Retinal fundus photograph. 1659 x 2212 pixels — 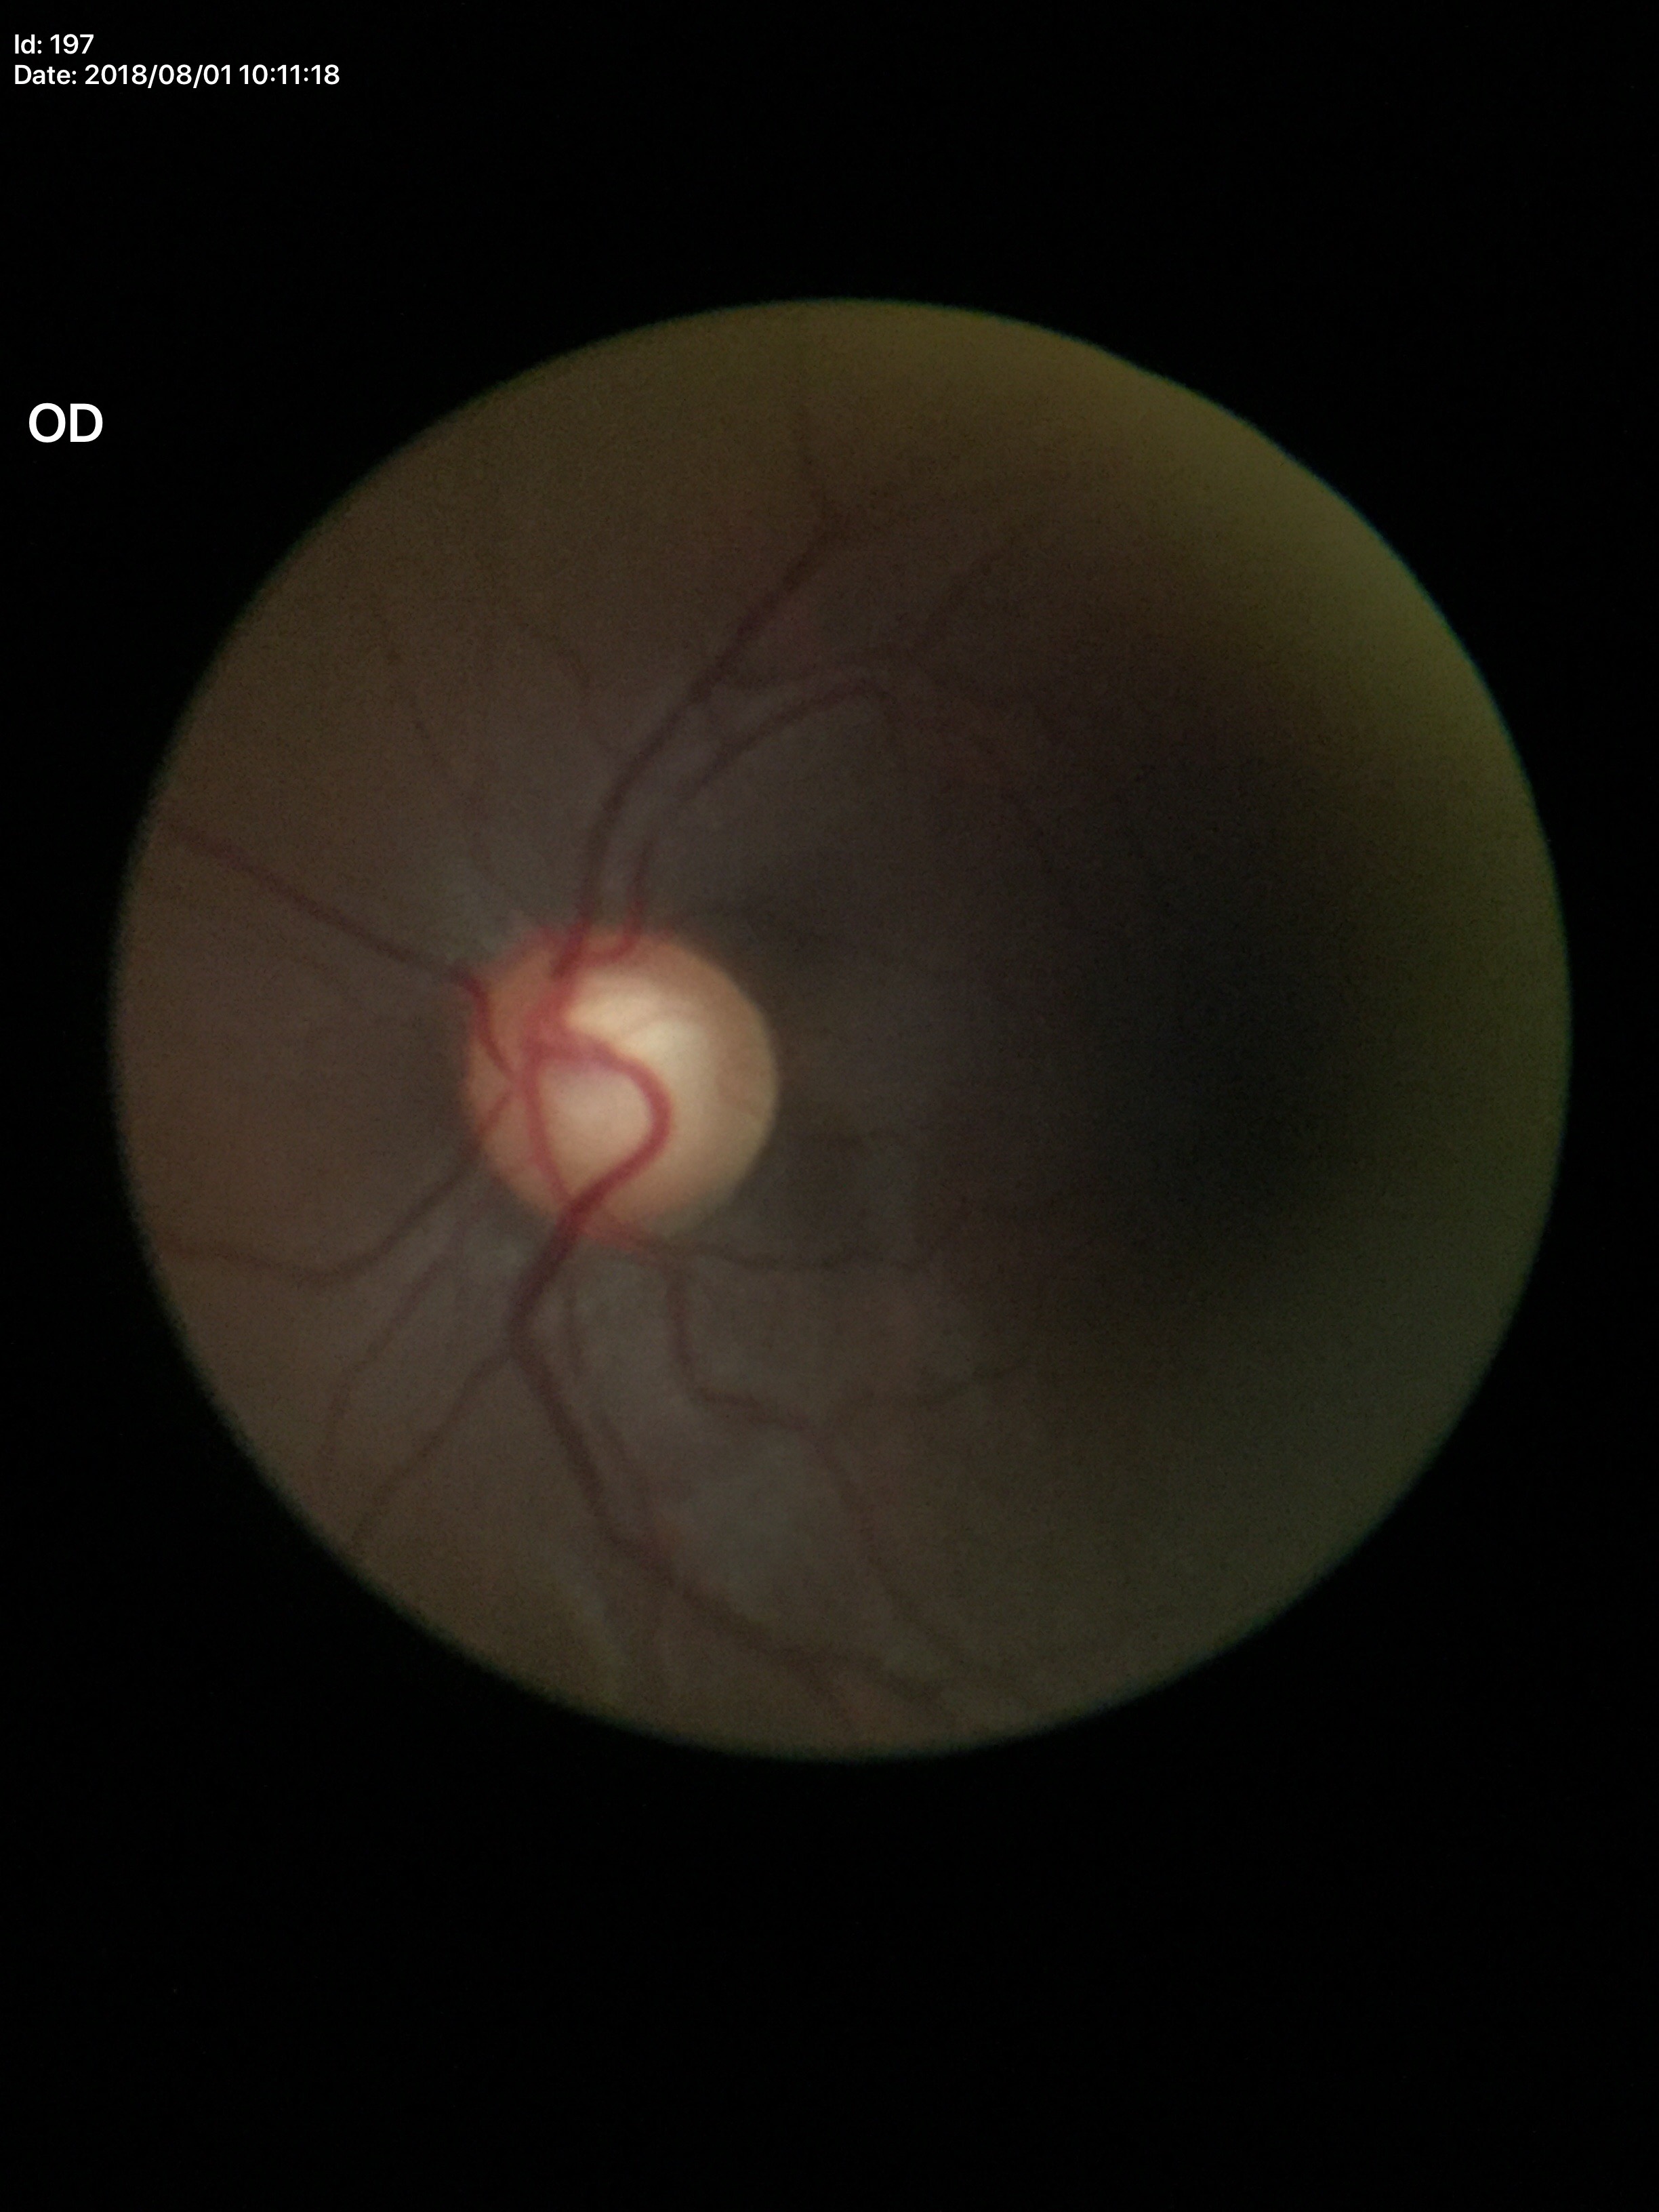

{
  "glaucoma_decision": "suspicious findings (5/5 ophthalmologists in agreement)",
  "vcdr": "0.68"
}